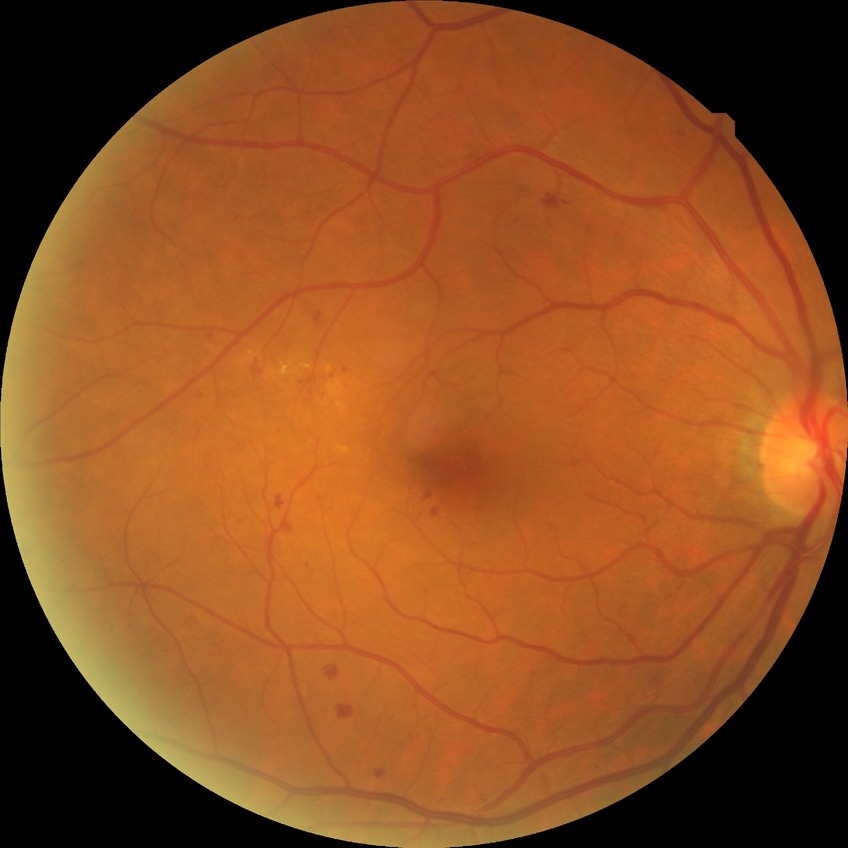
Modified Davis grading is simple diabetic retinopathy.